Color fundus image
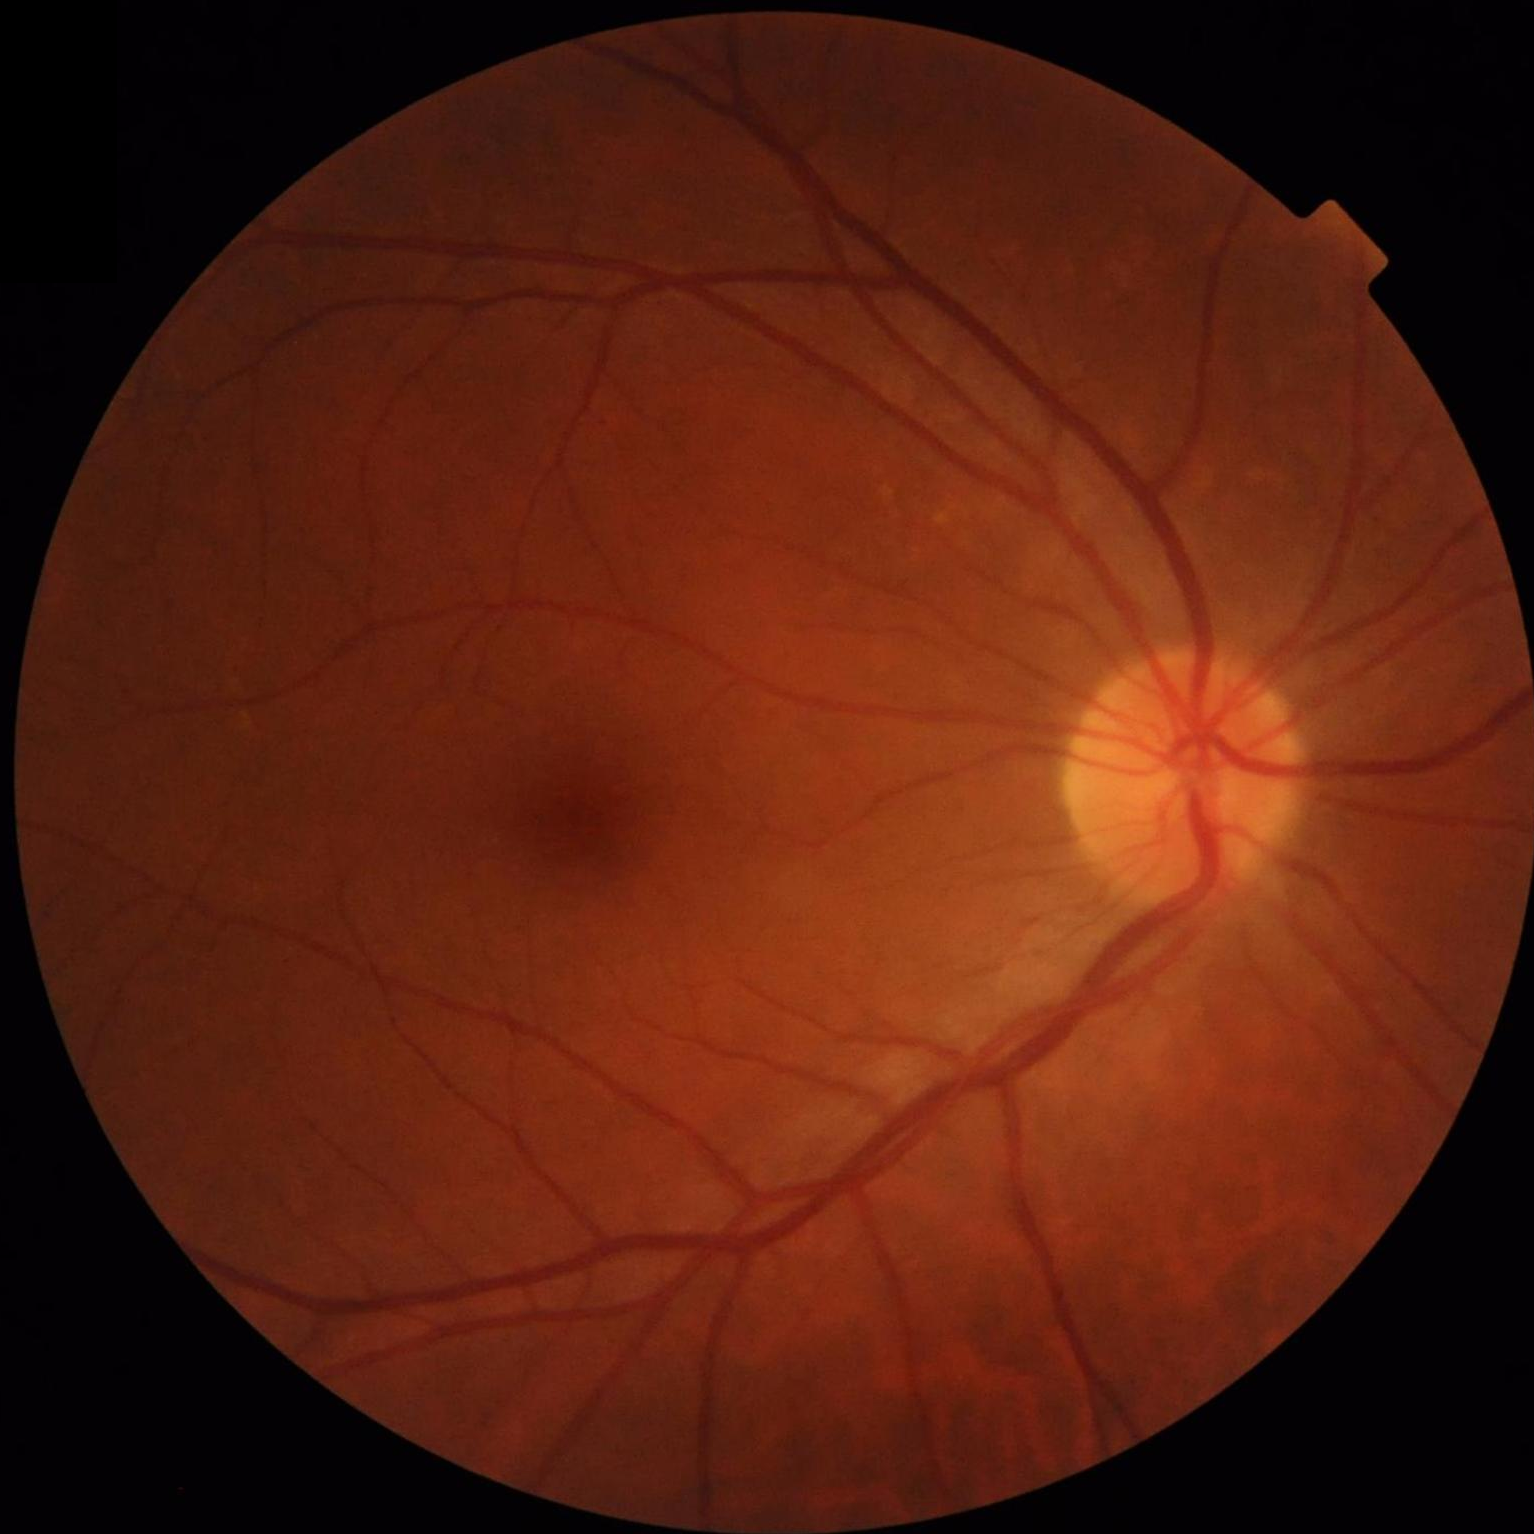
{"illumination": "satisfactory", "contrast": "satisfactory", "overall_quality": "adequate", "clarity": "in focus"}